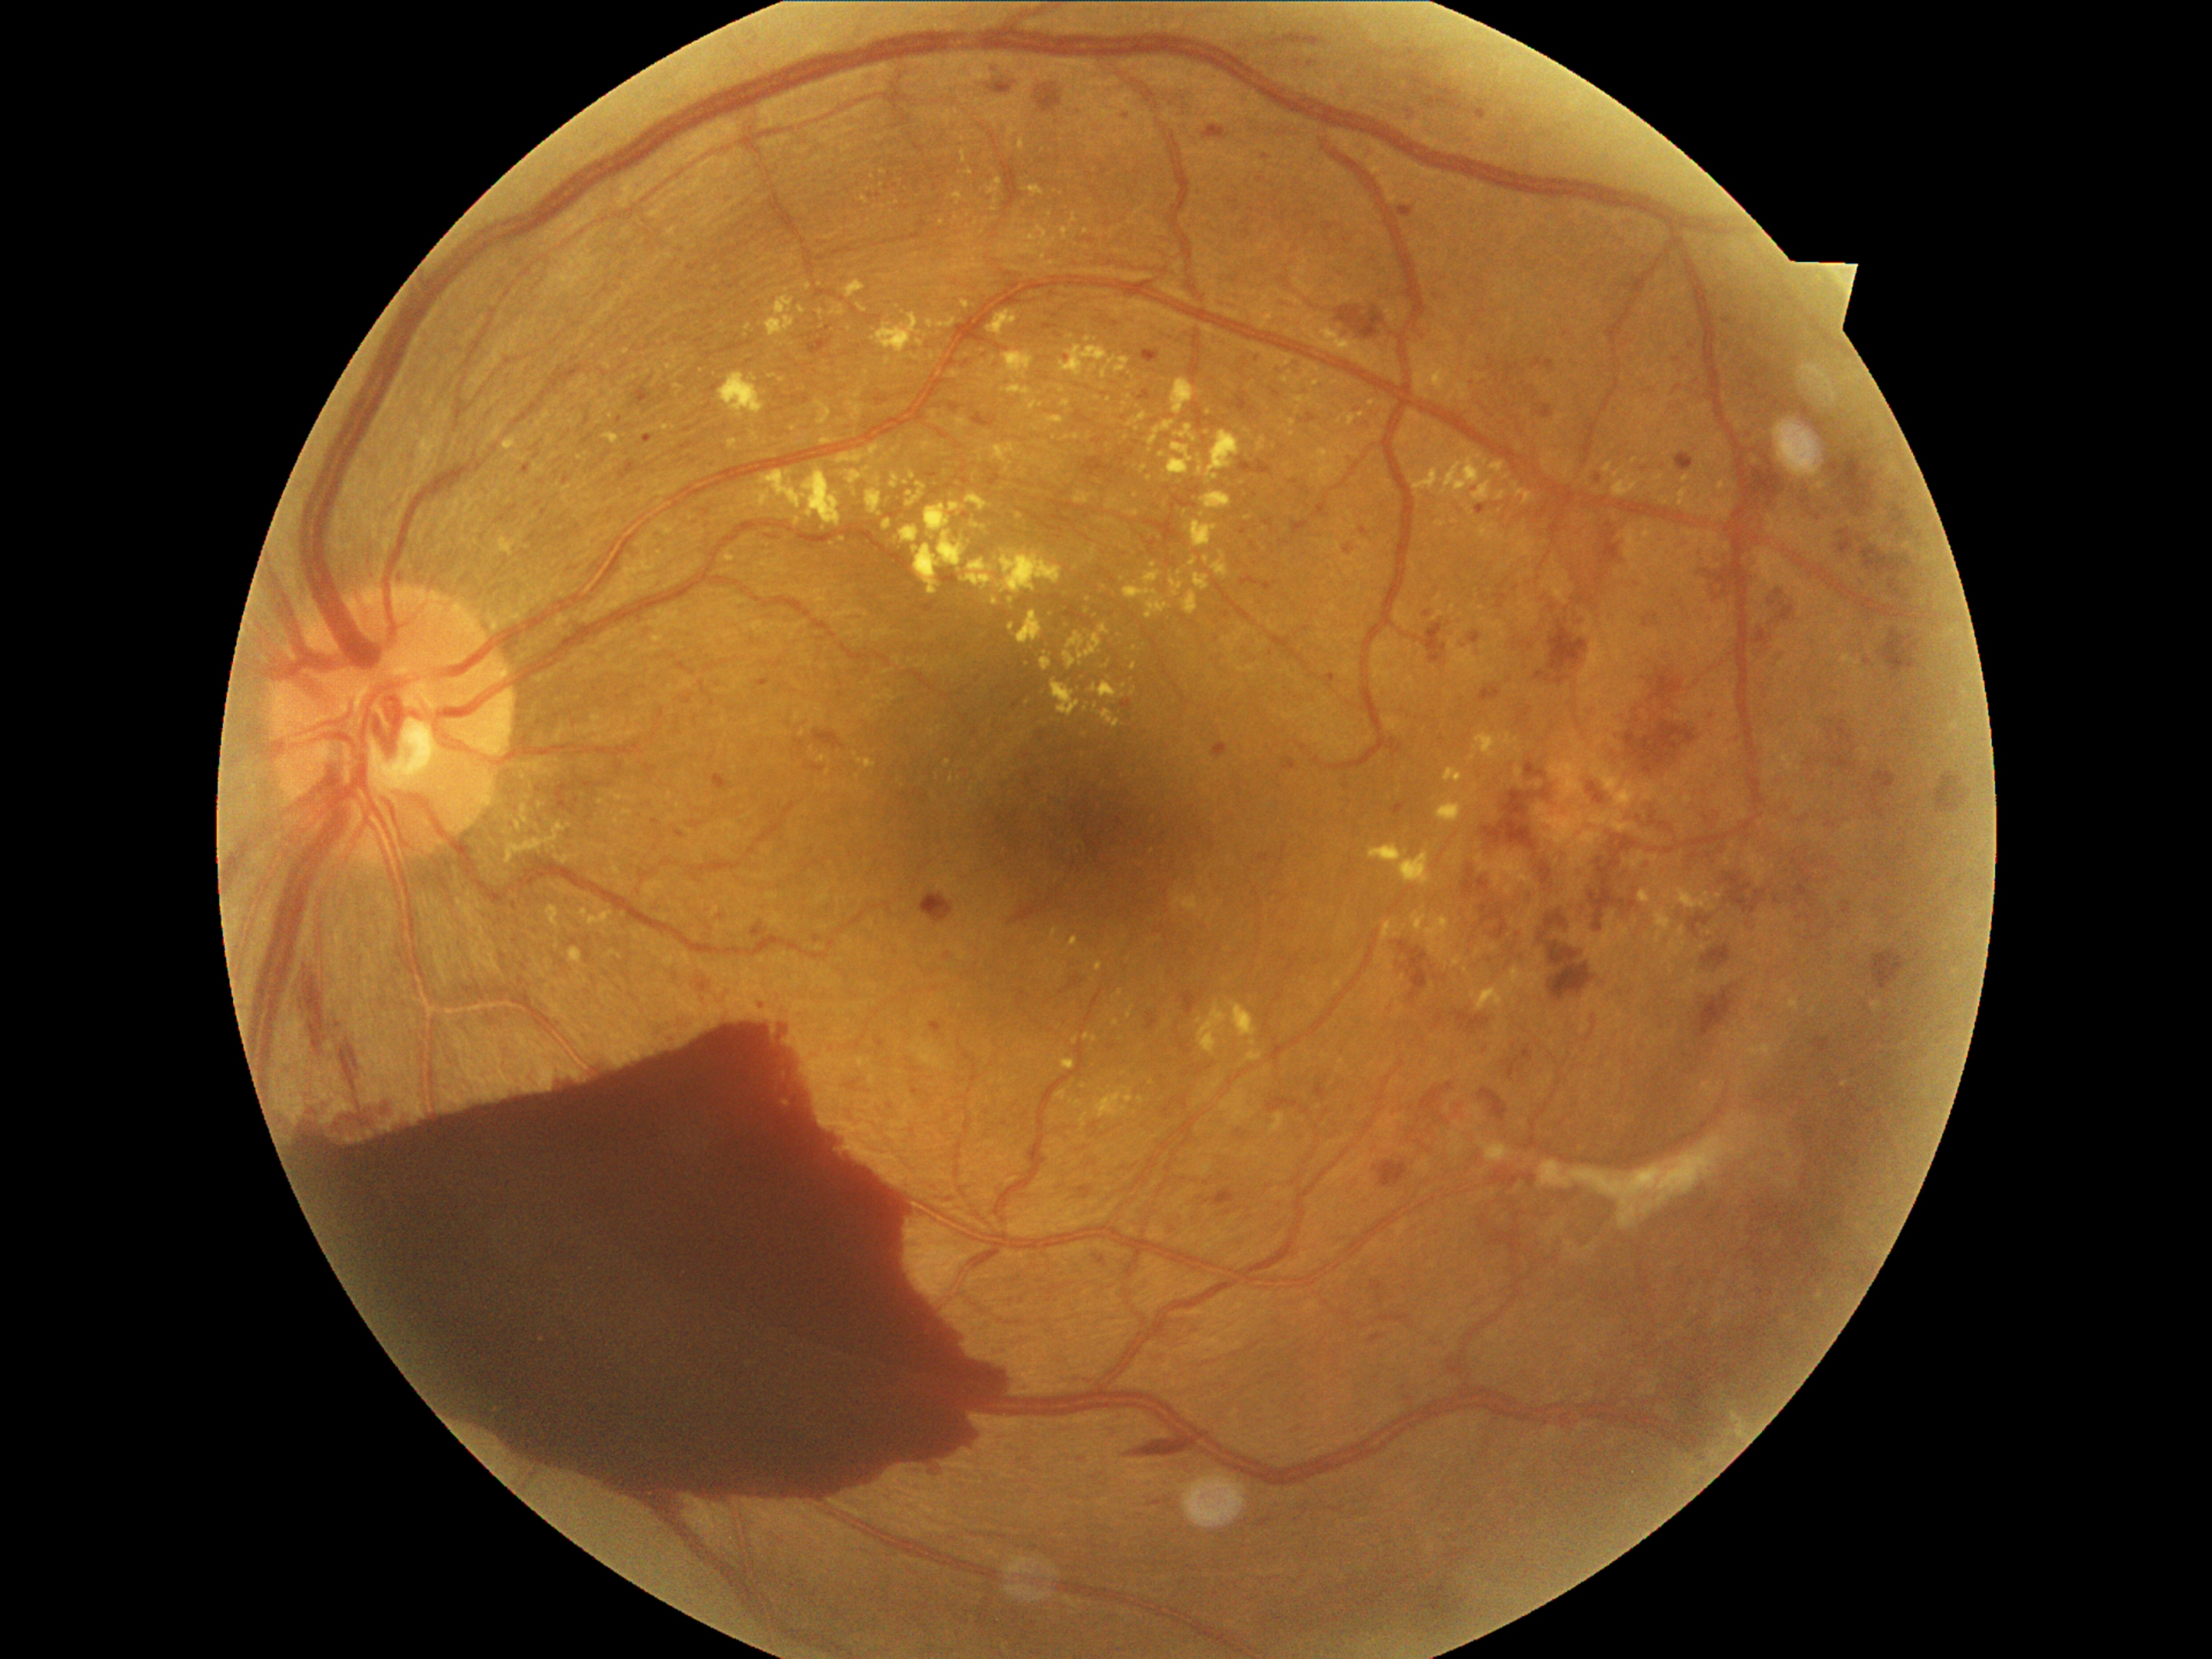

DR severity: grade 4 — neovascularization and/or vitreous/pre-retinal hemorrhage.